Image size 2048x1536, color fundus image — 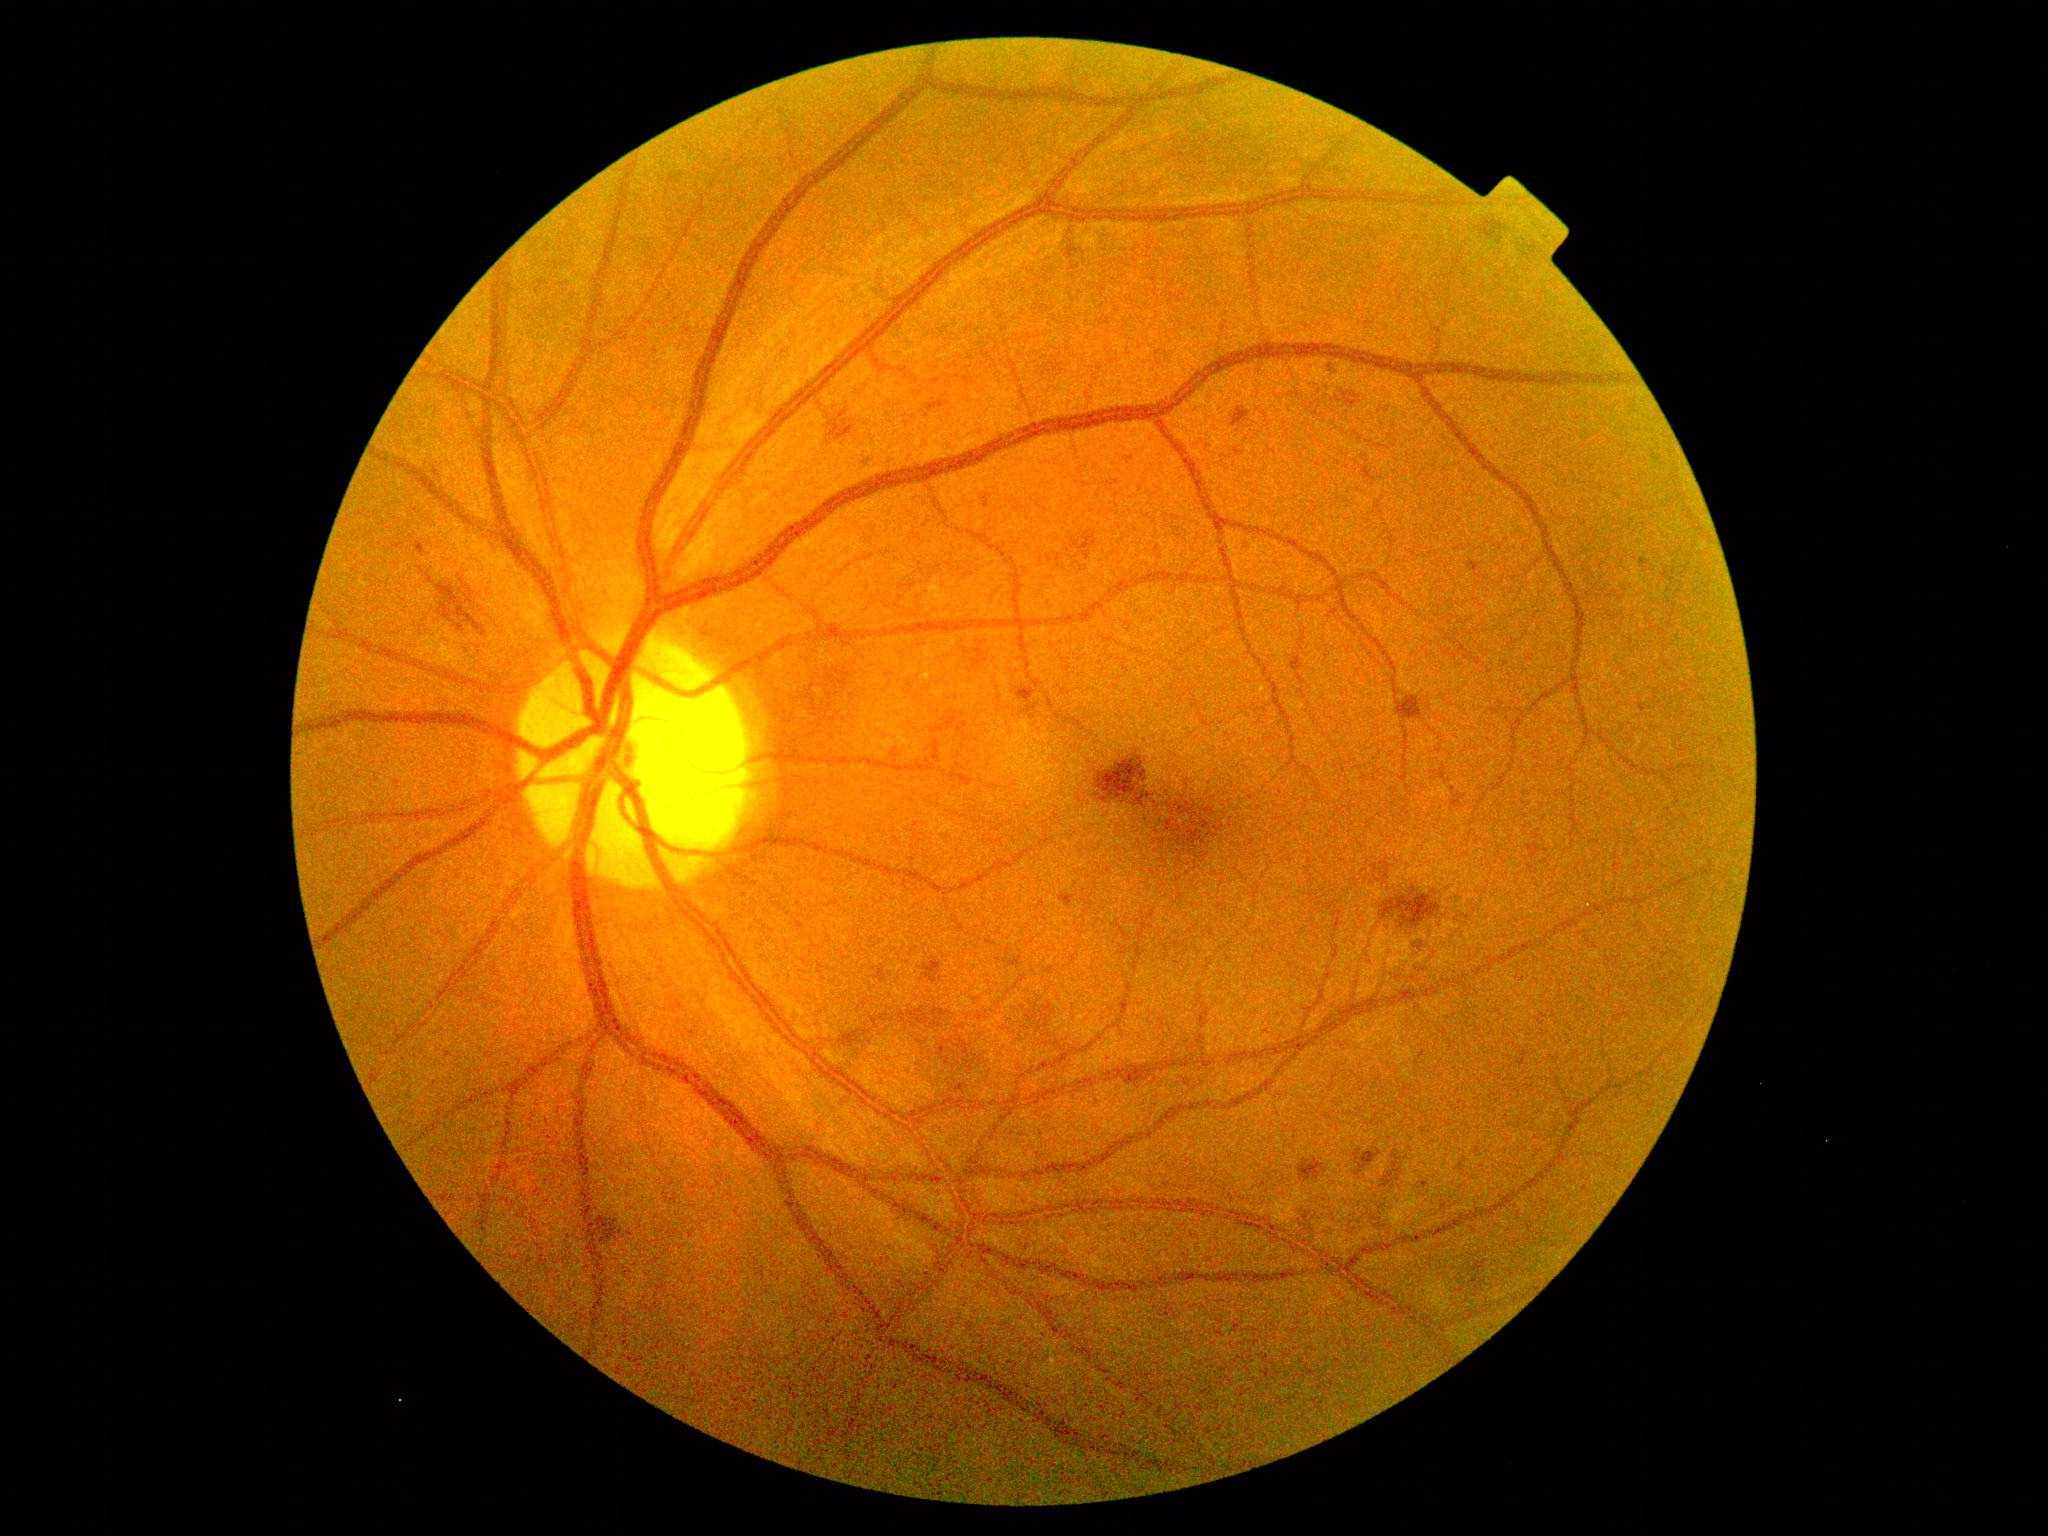

Retinopathy grade is 2.